Nonmydriatic. Posterior pole photograph. 45 degree fundus photograph — 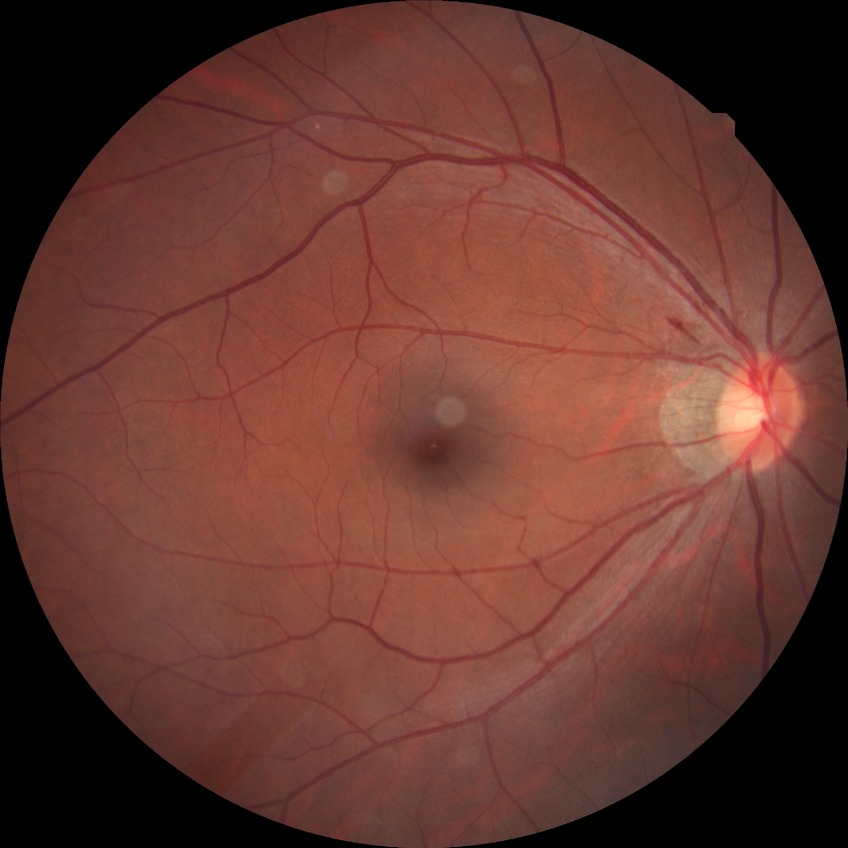

Diabetic retinopathy (DR) is simple diabetic retinopathy (SDR).